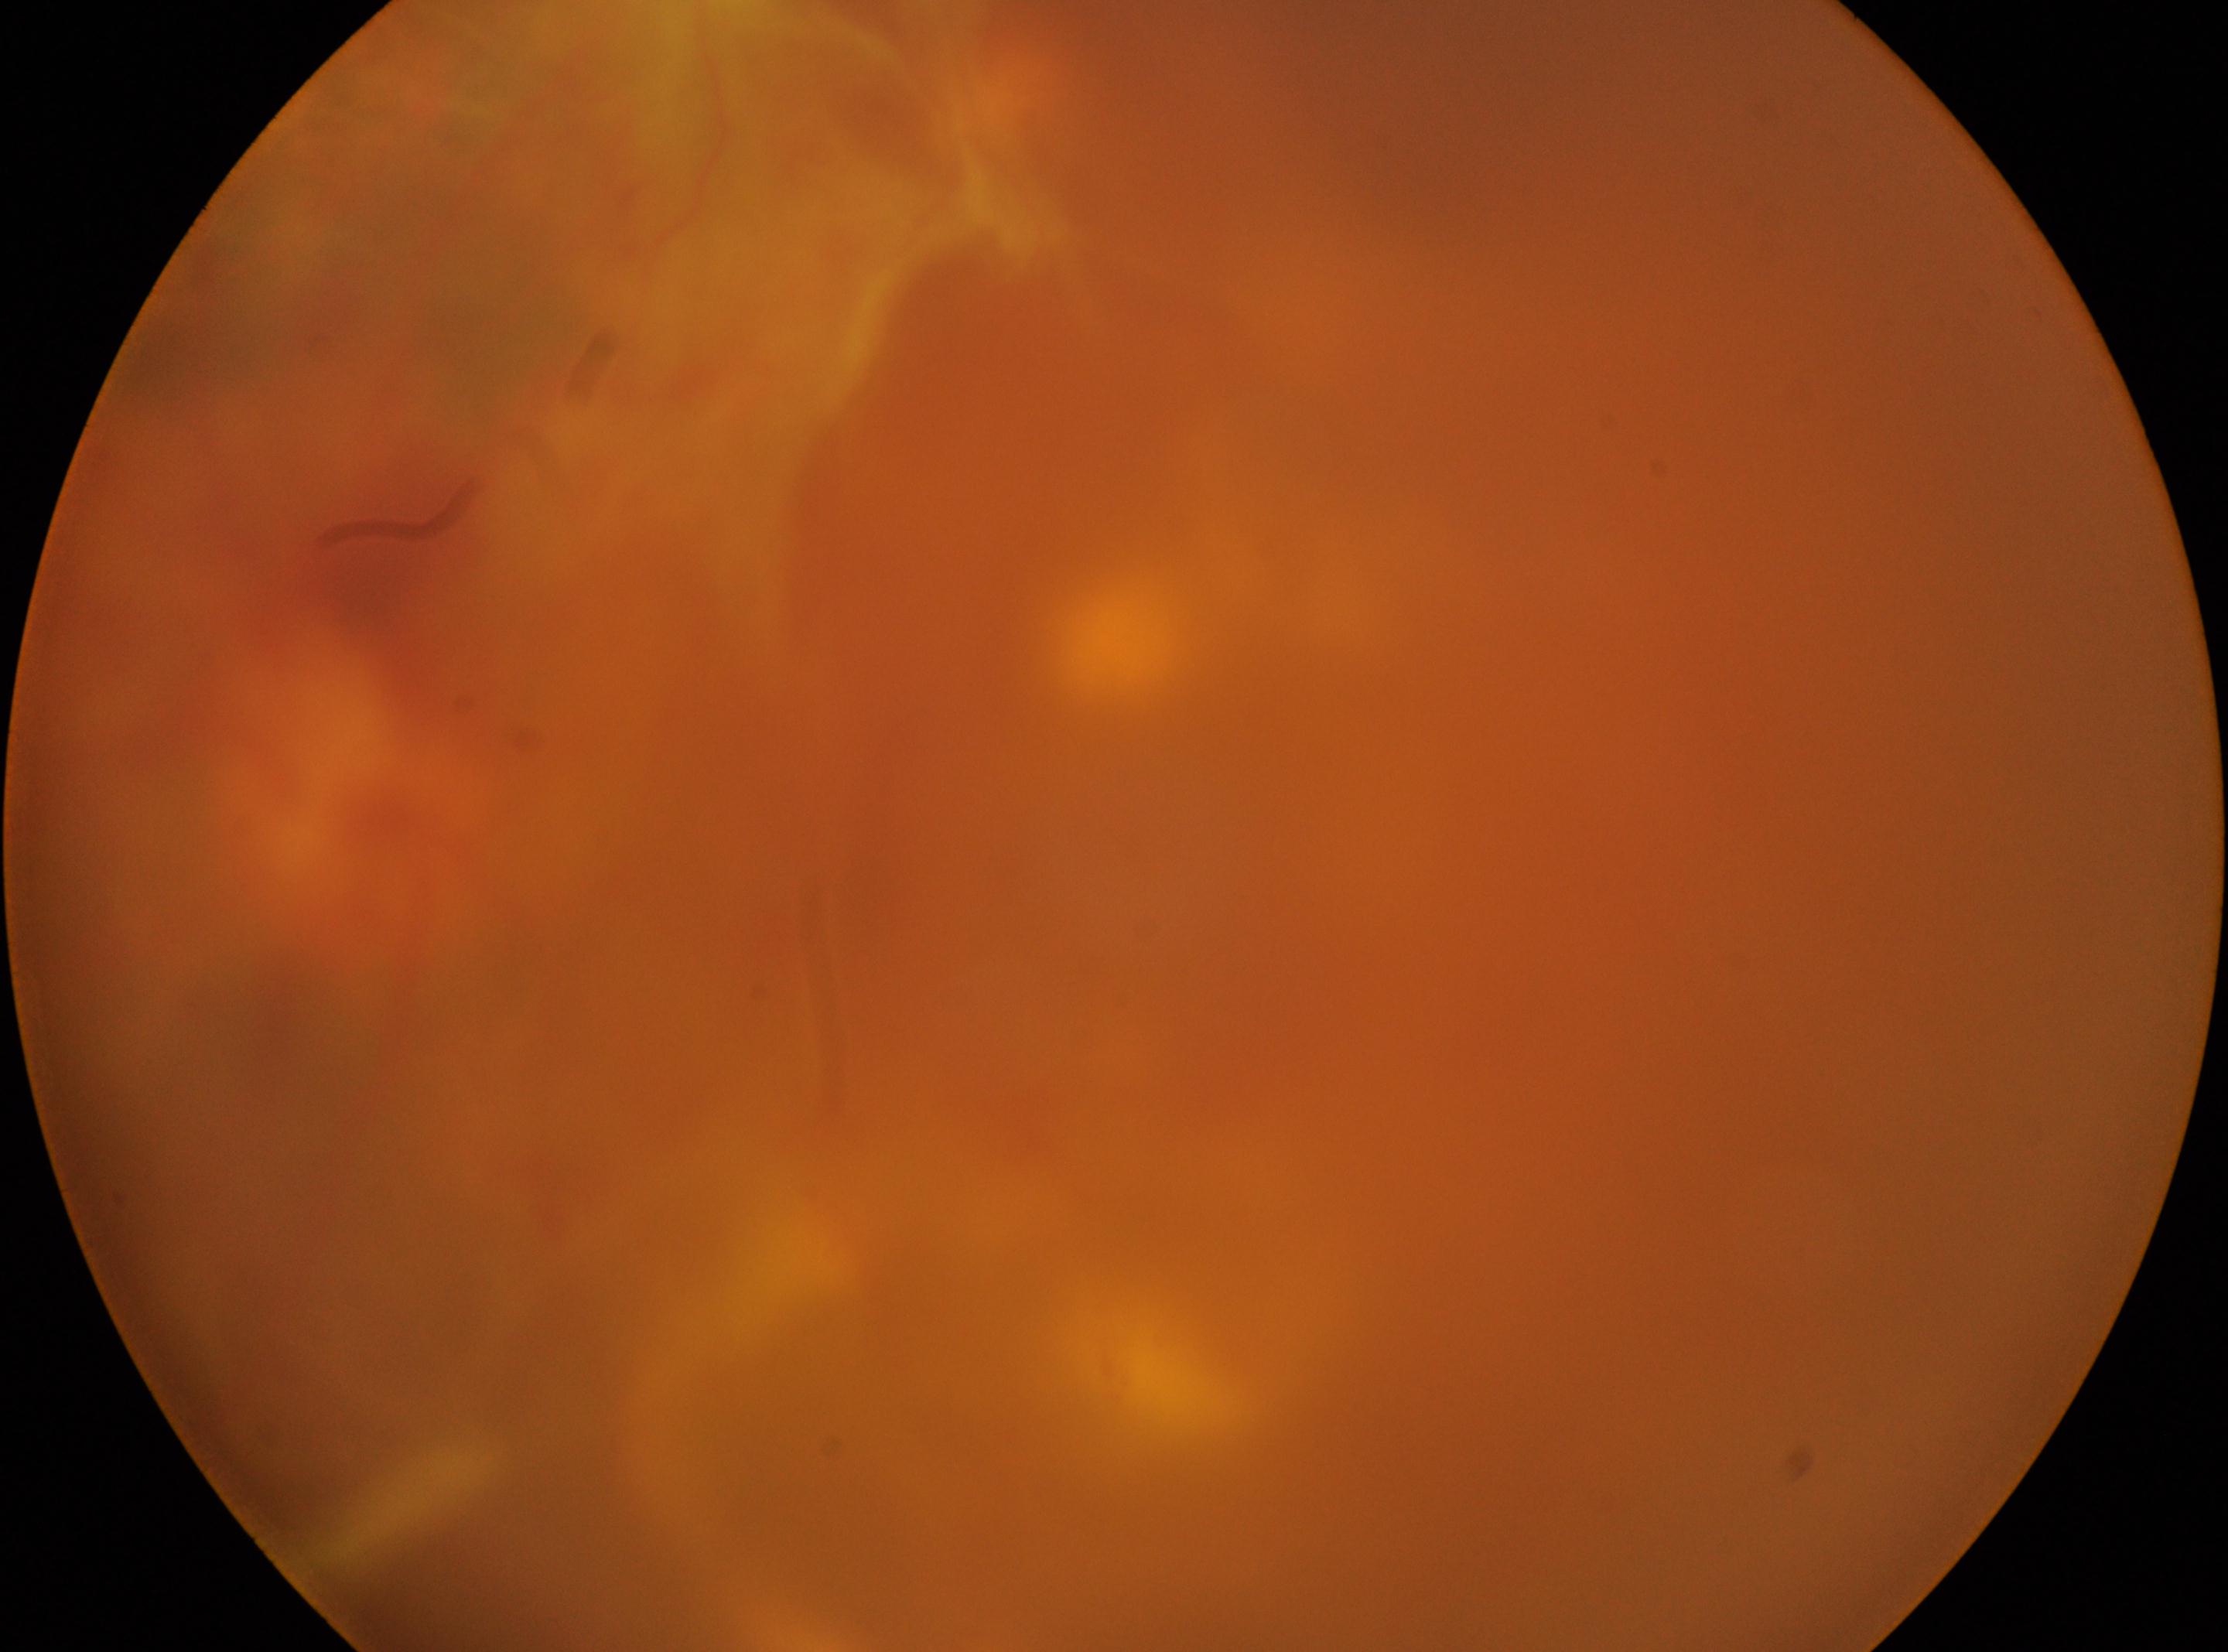

This is the oculus sinister.
Optic disc center: 351px, 780px.
Fovea centralis located at 1086px, 889px.
DR stage: PDR (grade 4).